1240x1240px. Wide-field fundus photograph from neonatal ROP screening.
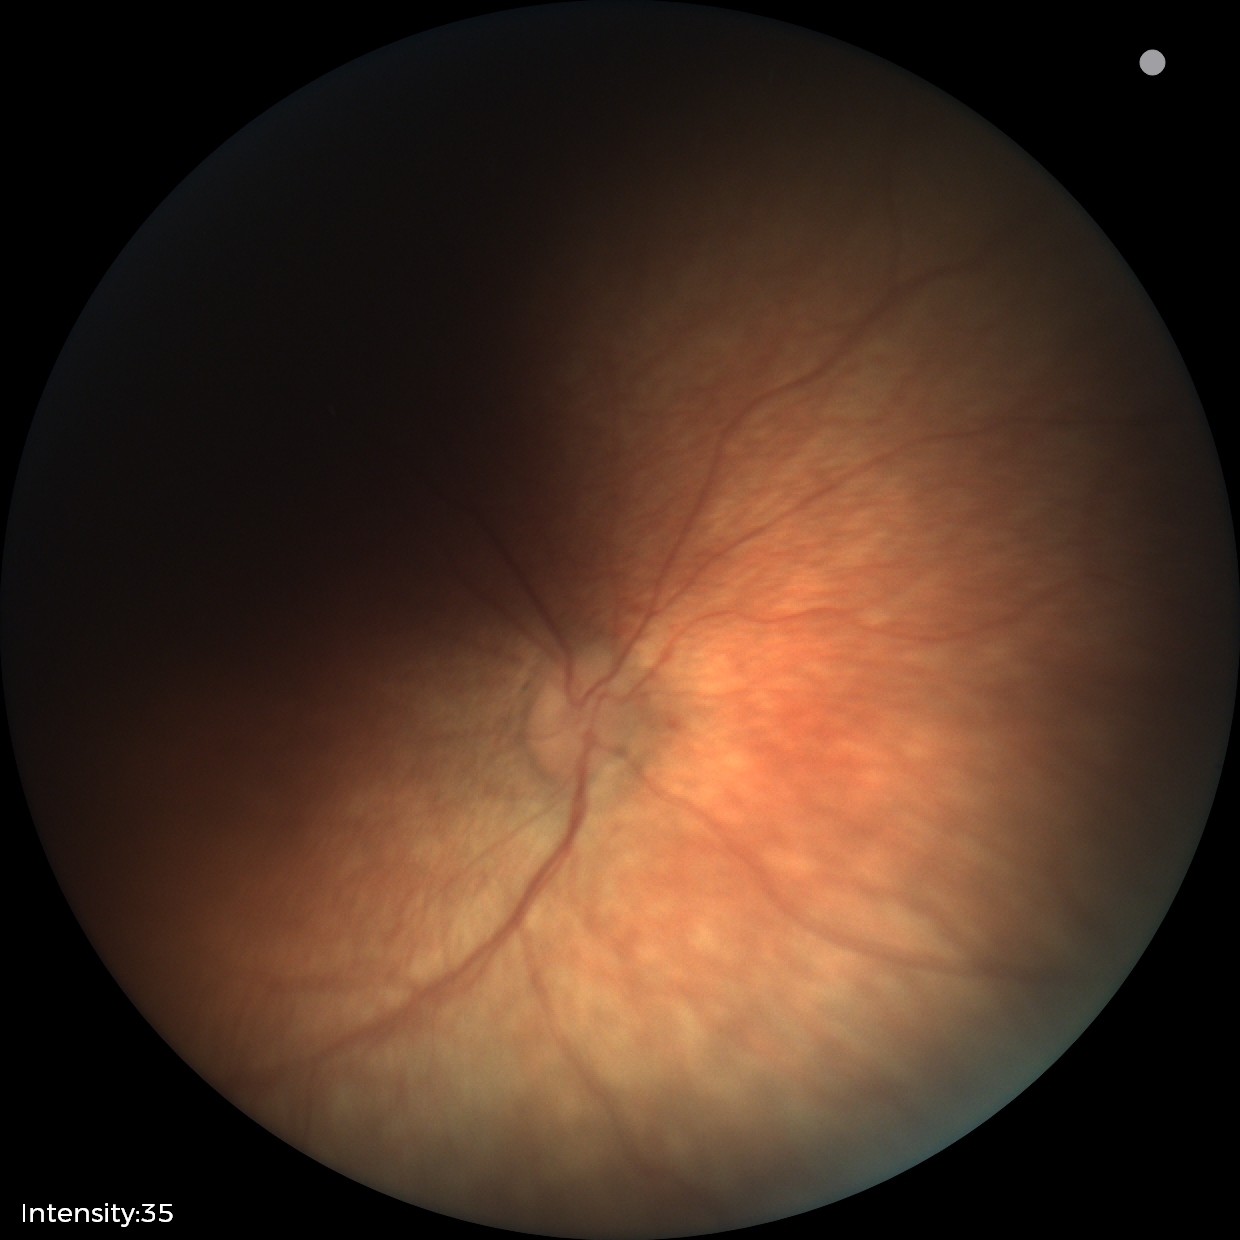
Assessment: physiological appearance with no retinal pathology.